Image size 640x480 · pediatric retinal photograph (wide-field).
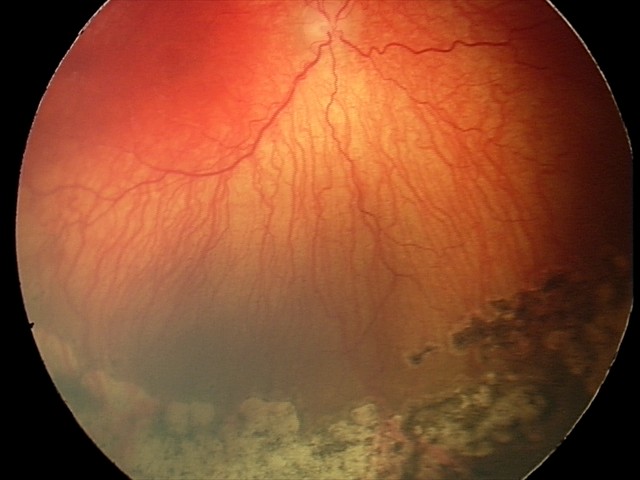 Screening: plus disease | A-ROP (aggressive ROP) — rapidly progressive severe ROP with prominent plus disease, often without classic stage progression.